1440x1080 · pediatric retinal photograph (wide-field)
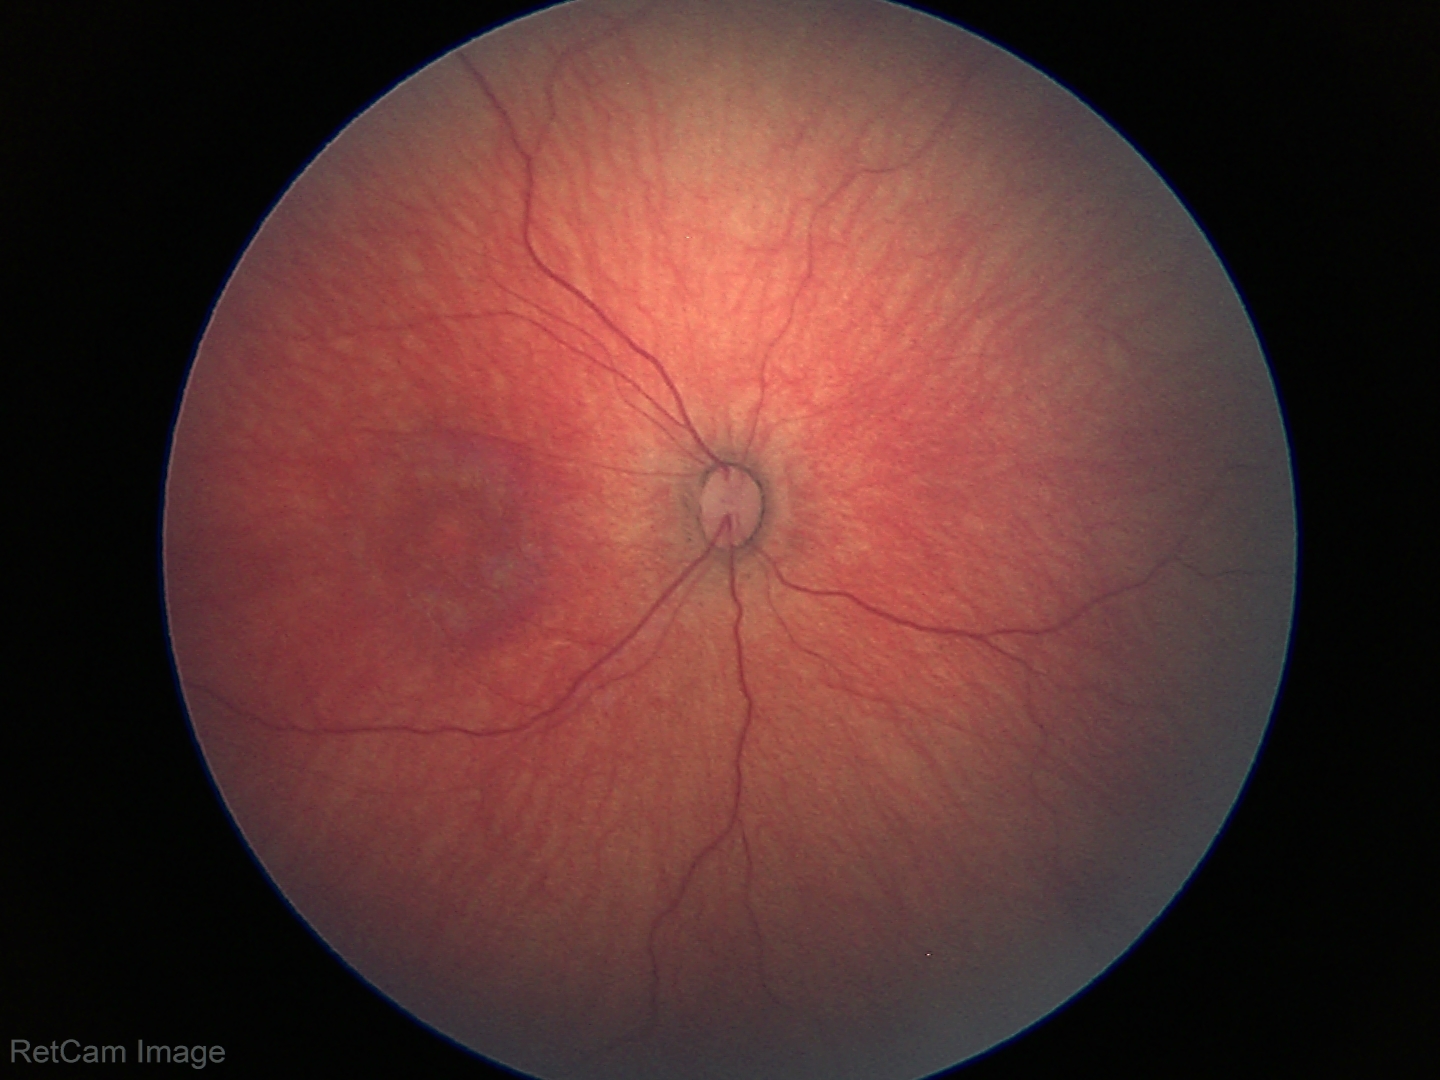

Finding: normal retinal appearance.